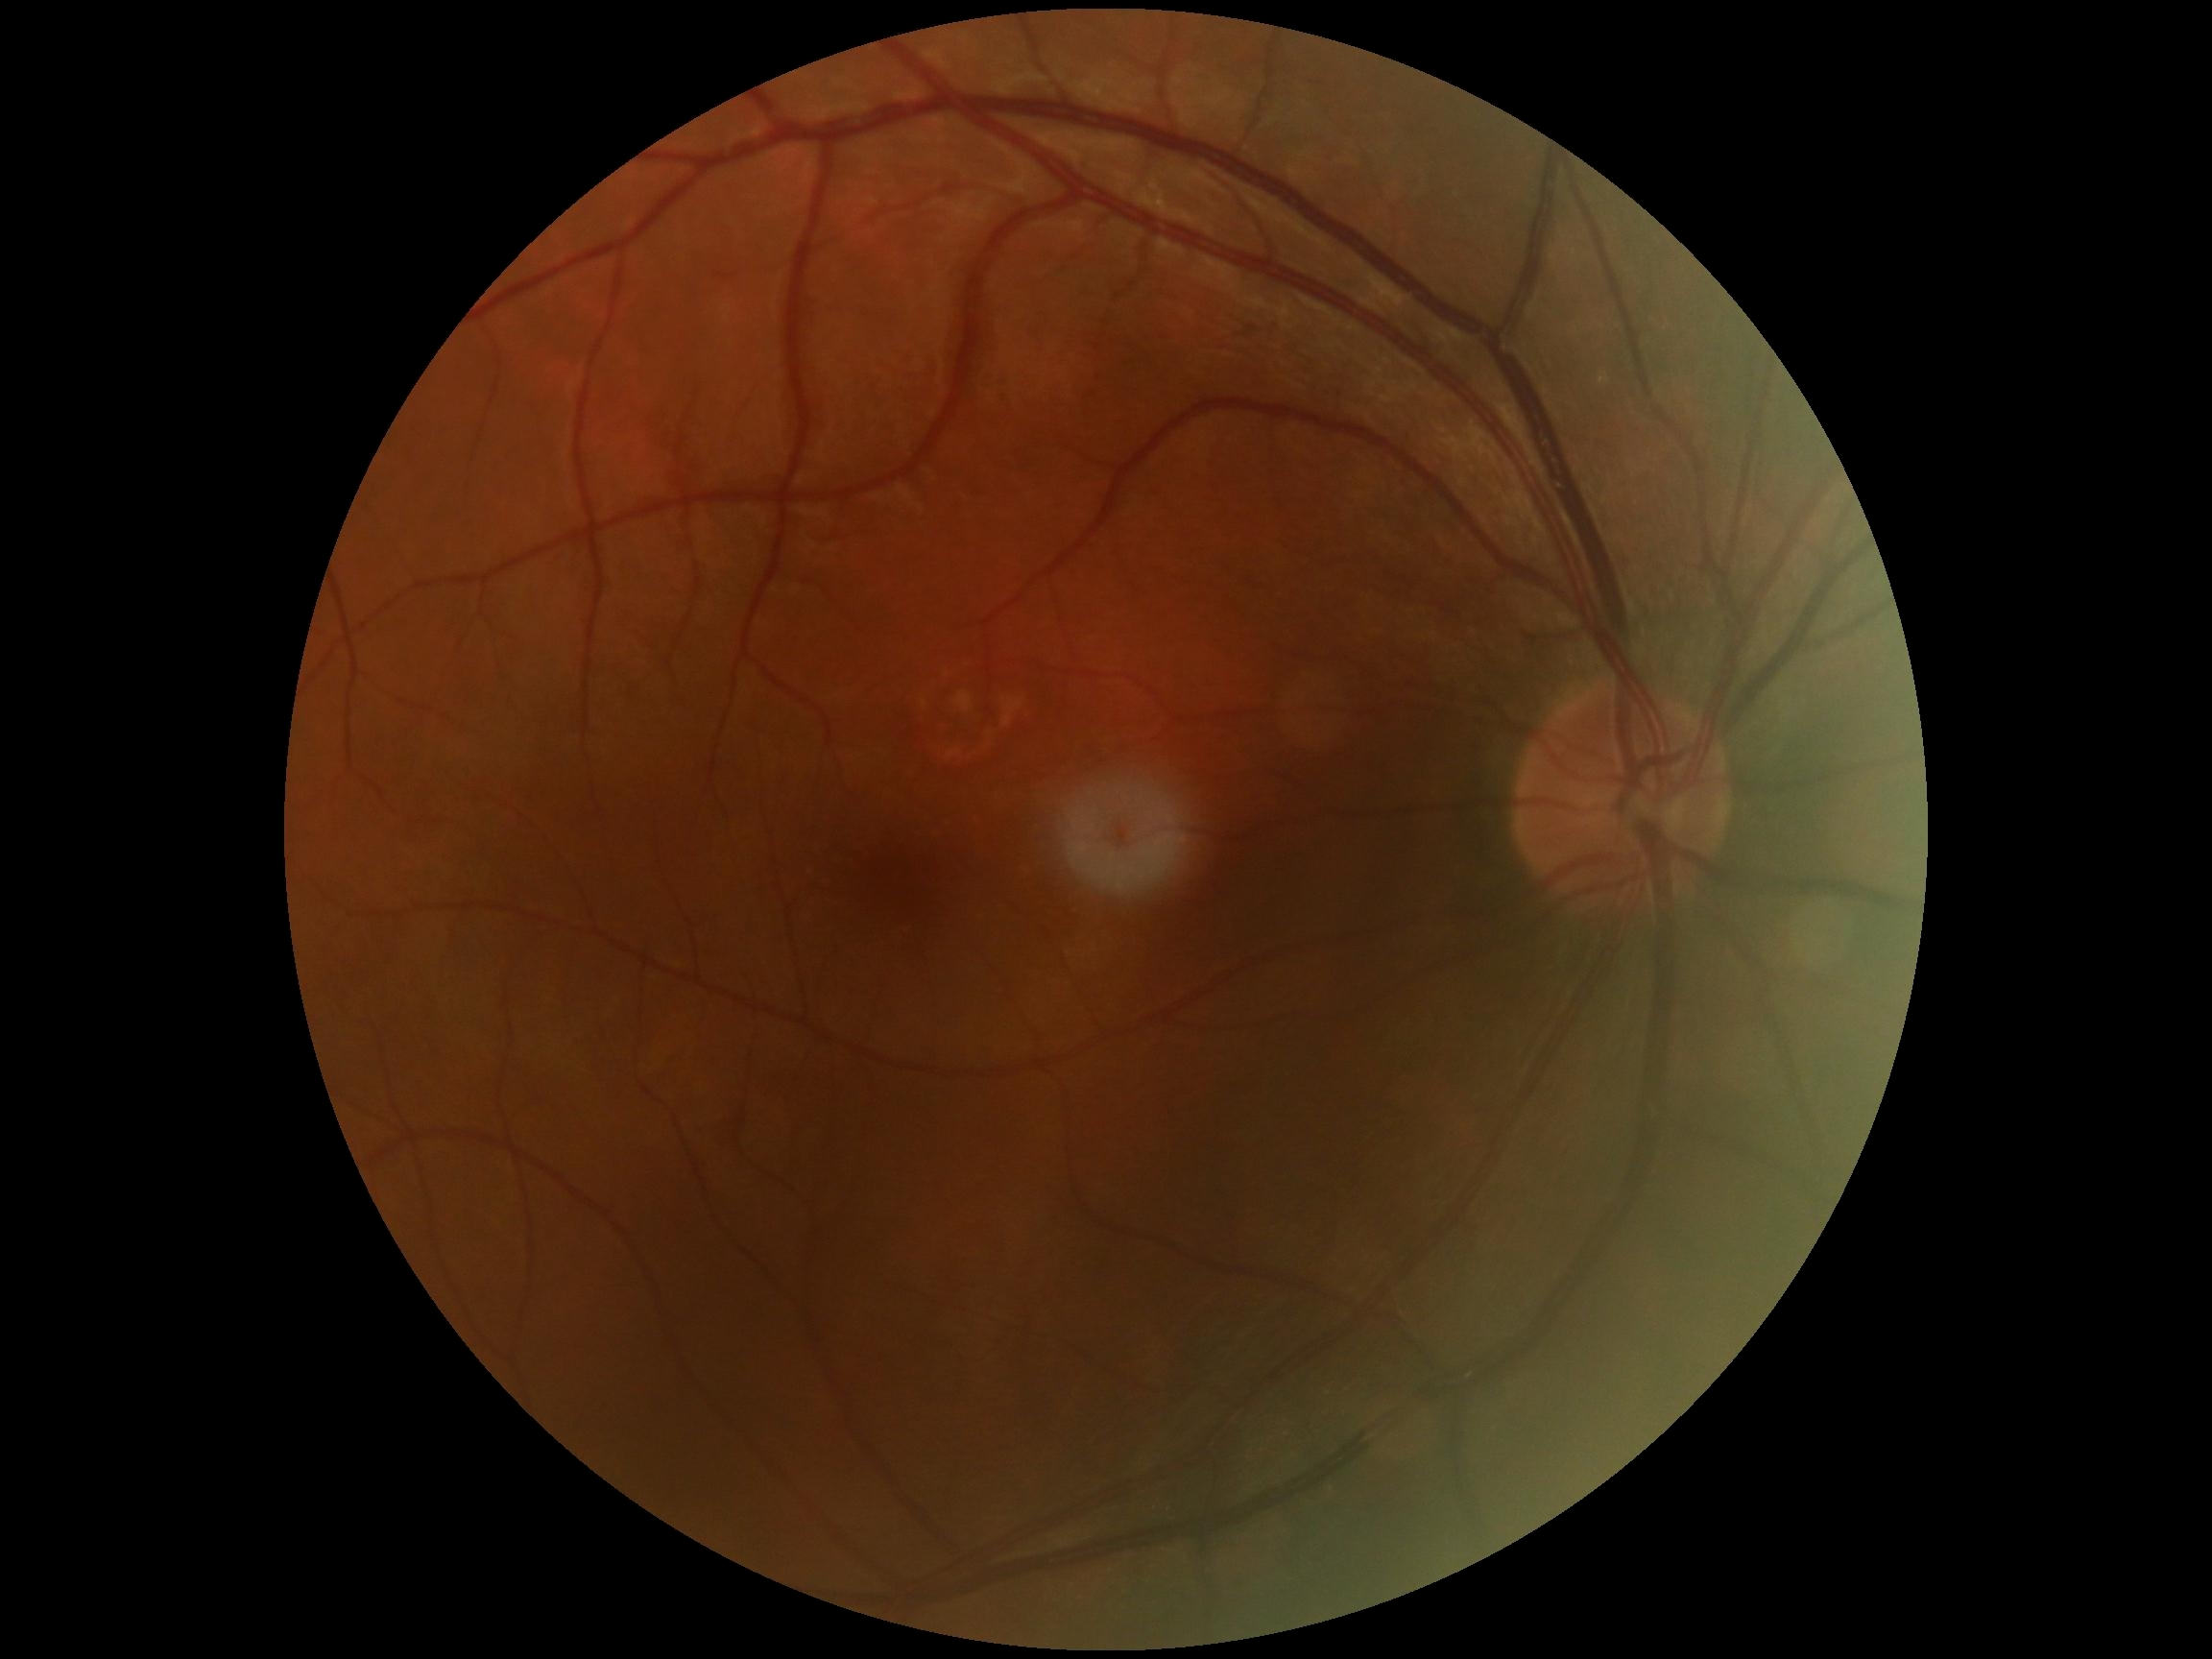 Diabetic retinopathy severity: grade 0 — no visible signs of diabetic retinopathy.